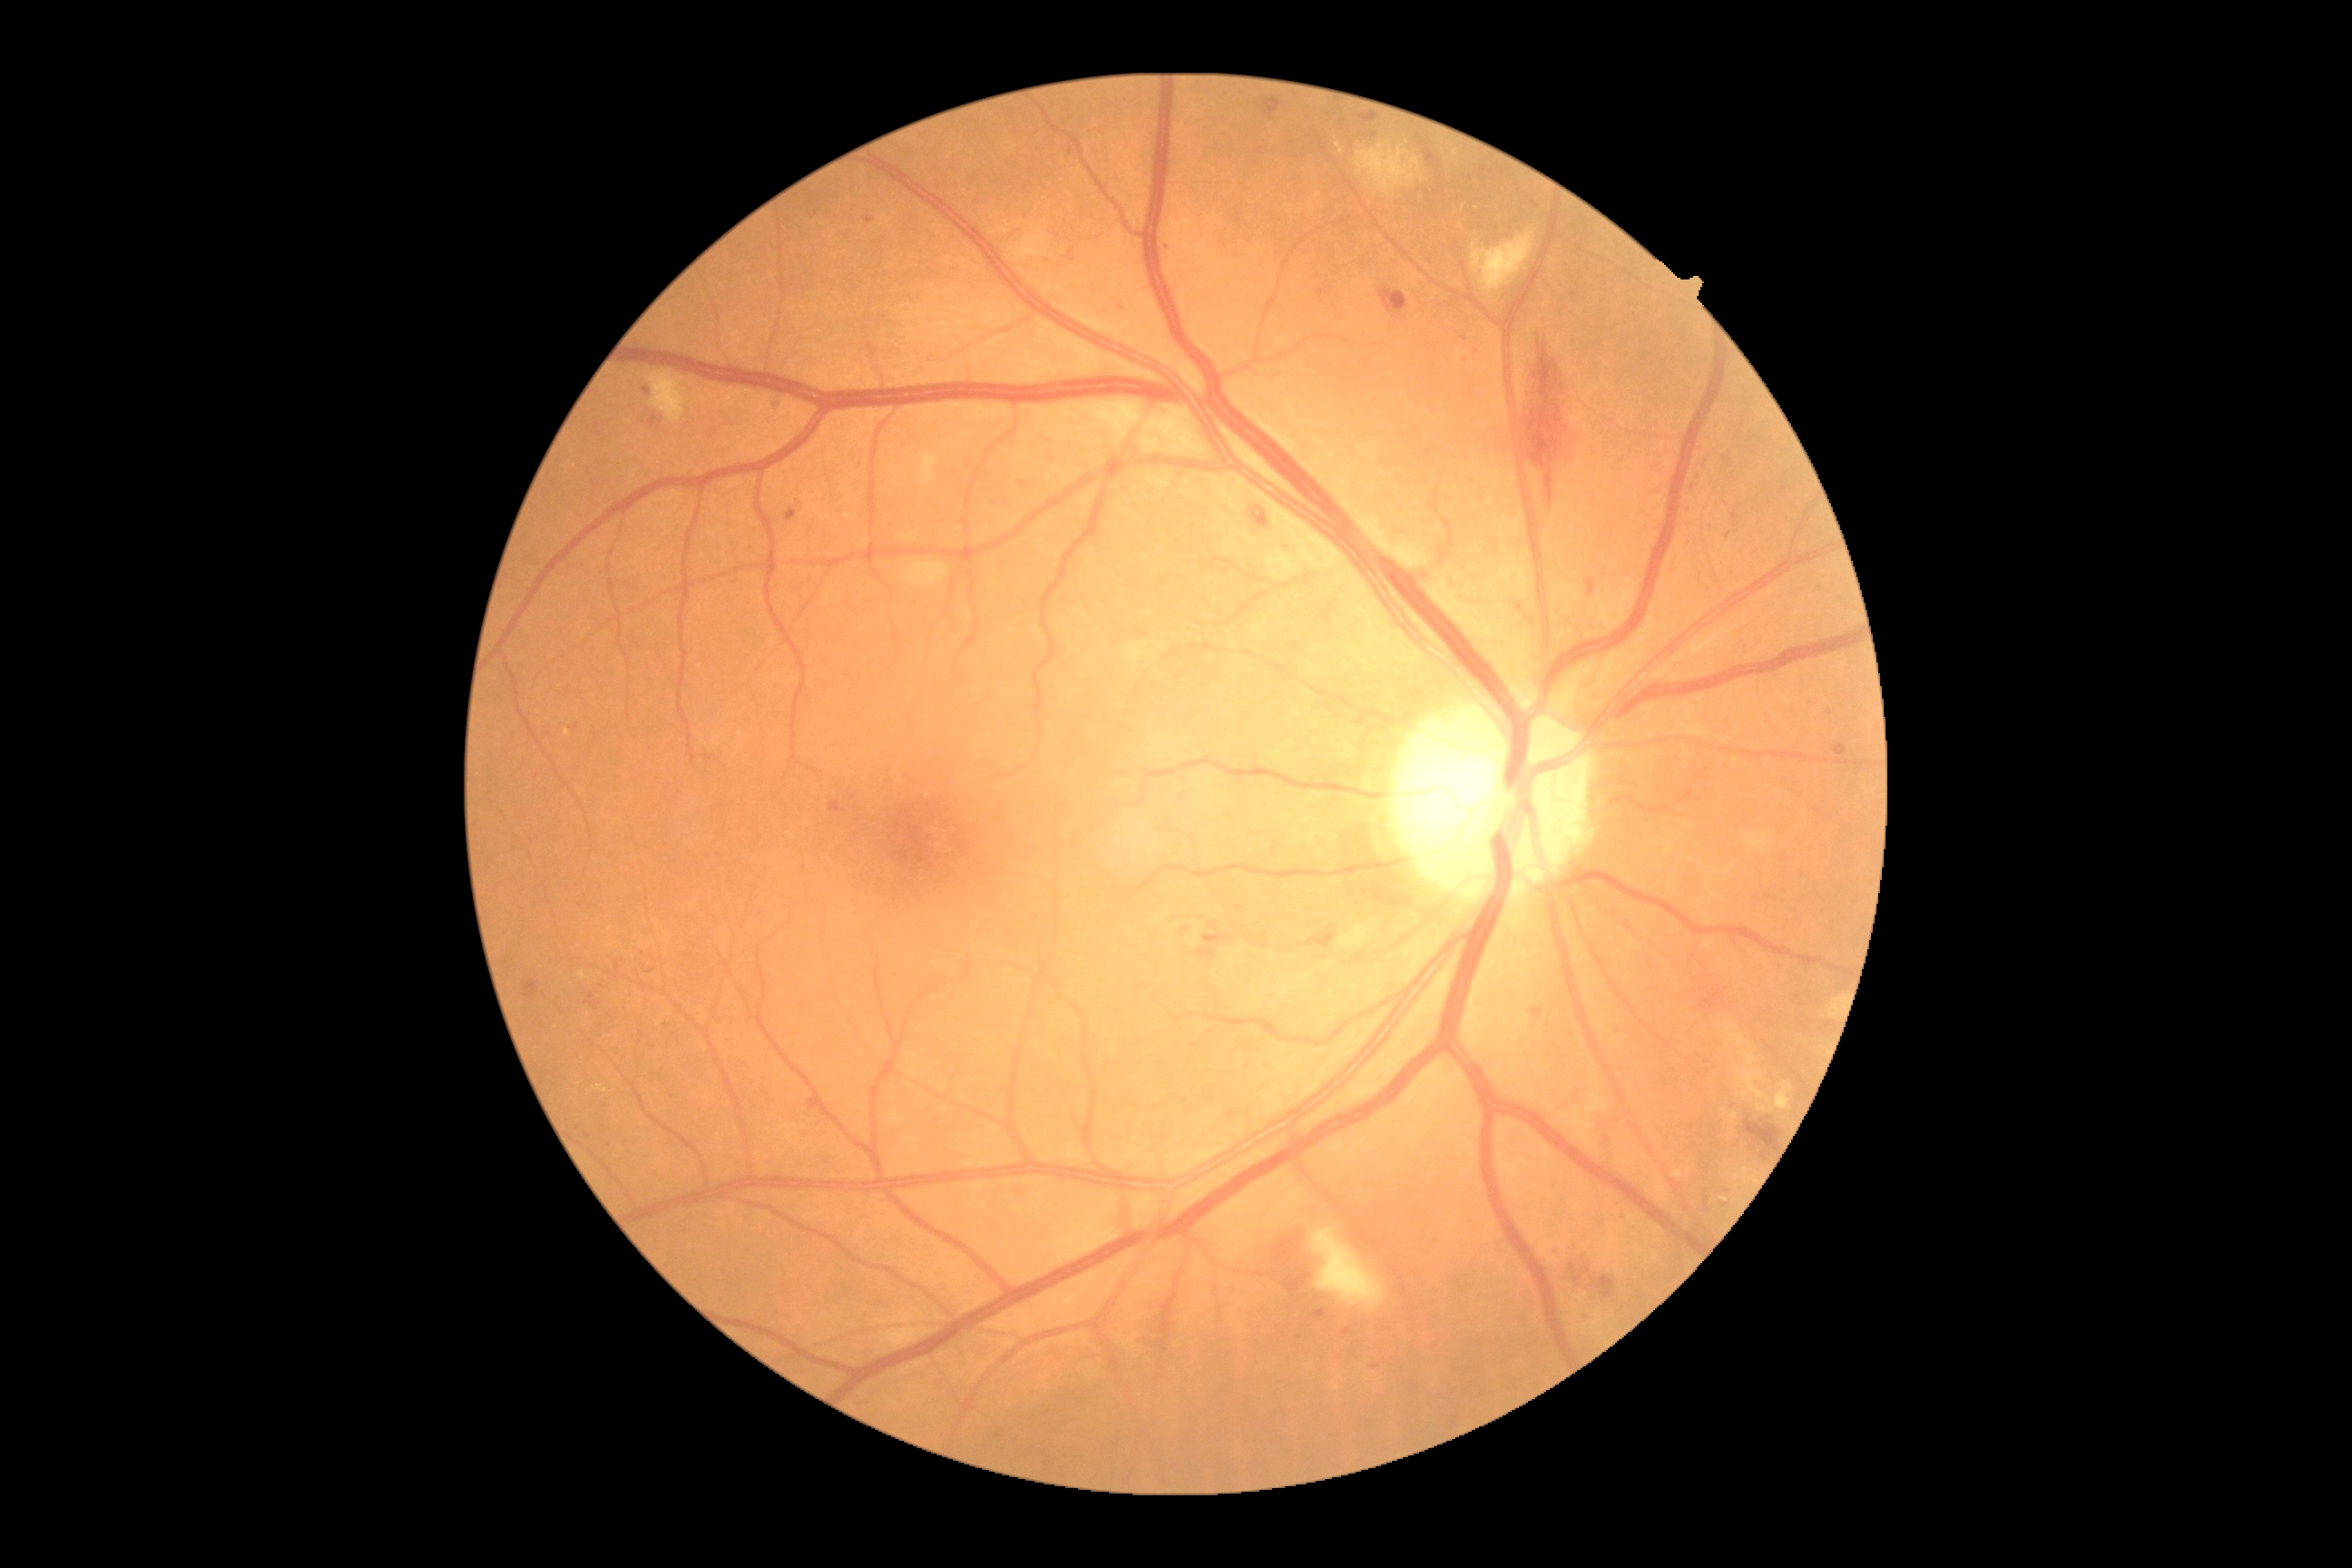

DR stage is moderate non-proliferative diabetic retinopathy (grade 2). MAs include lesions at bbox(1475, 342, 1478, 351), bbox(1533, 1010, 1544, 1017), bbox(1612, 1197, 1620, 1206), bbox(651, 416, 663, 427), bbox(1066, 250, 1075, 262), bbox(1834, 743, 1848, 758). Small MAs approximately at (1374, 1366), (1830, 712), (598, 427), (577, 728), (1182, 799), (1374, 135), (1699, 475), (870, 220).